Color fundus image; Davis DR grading; FOV: 45 degrees; camera: NIDEK AFC-230; 848 x 848 pixels.
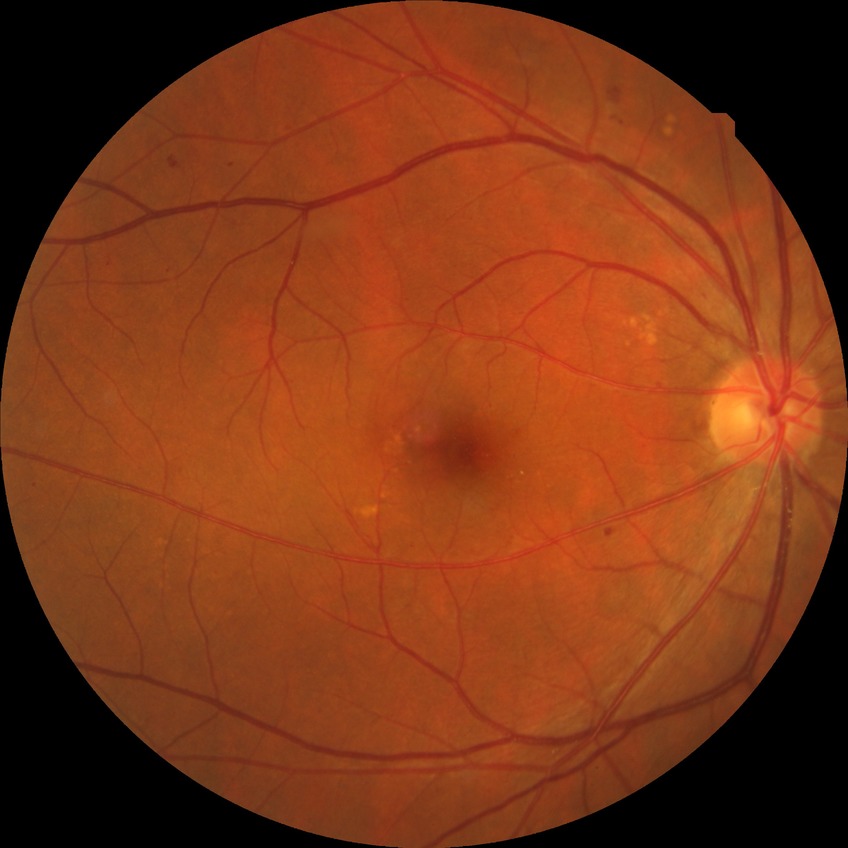
diabetic retinopathy (DR)@SDR (simple diabetic retinopathy).